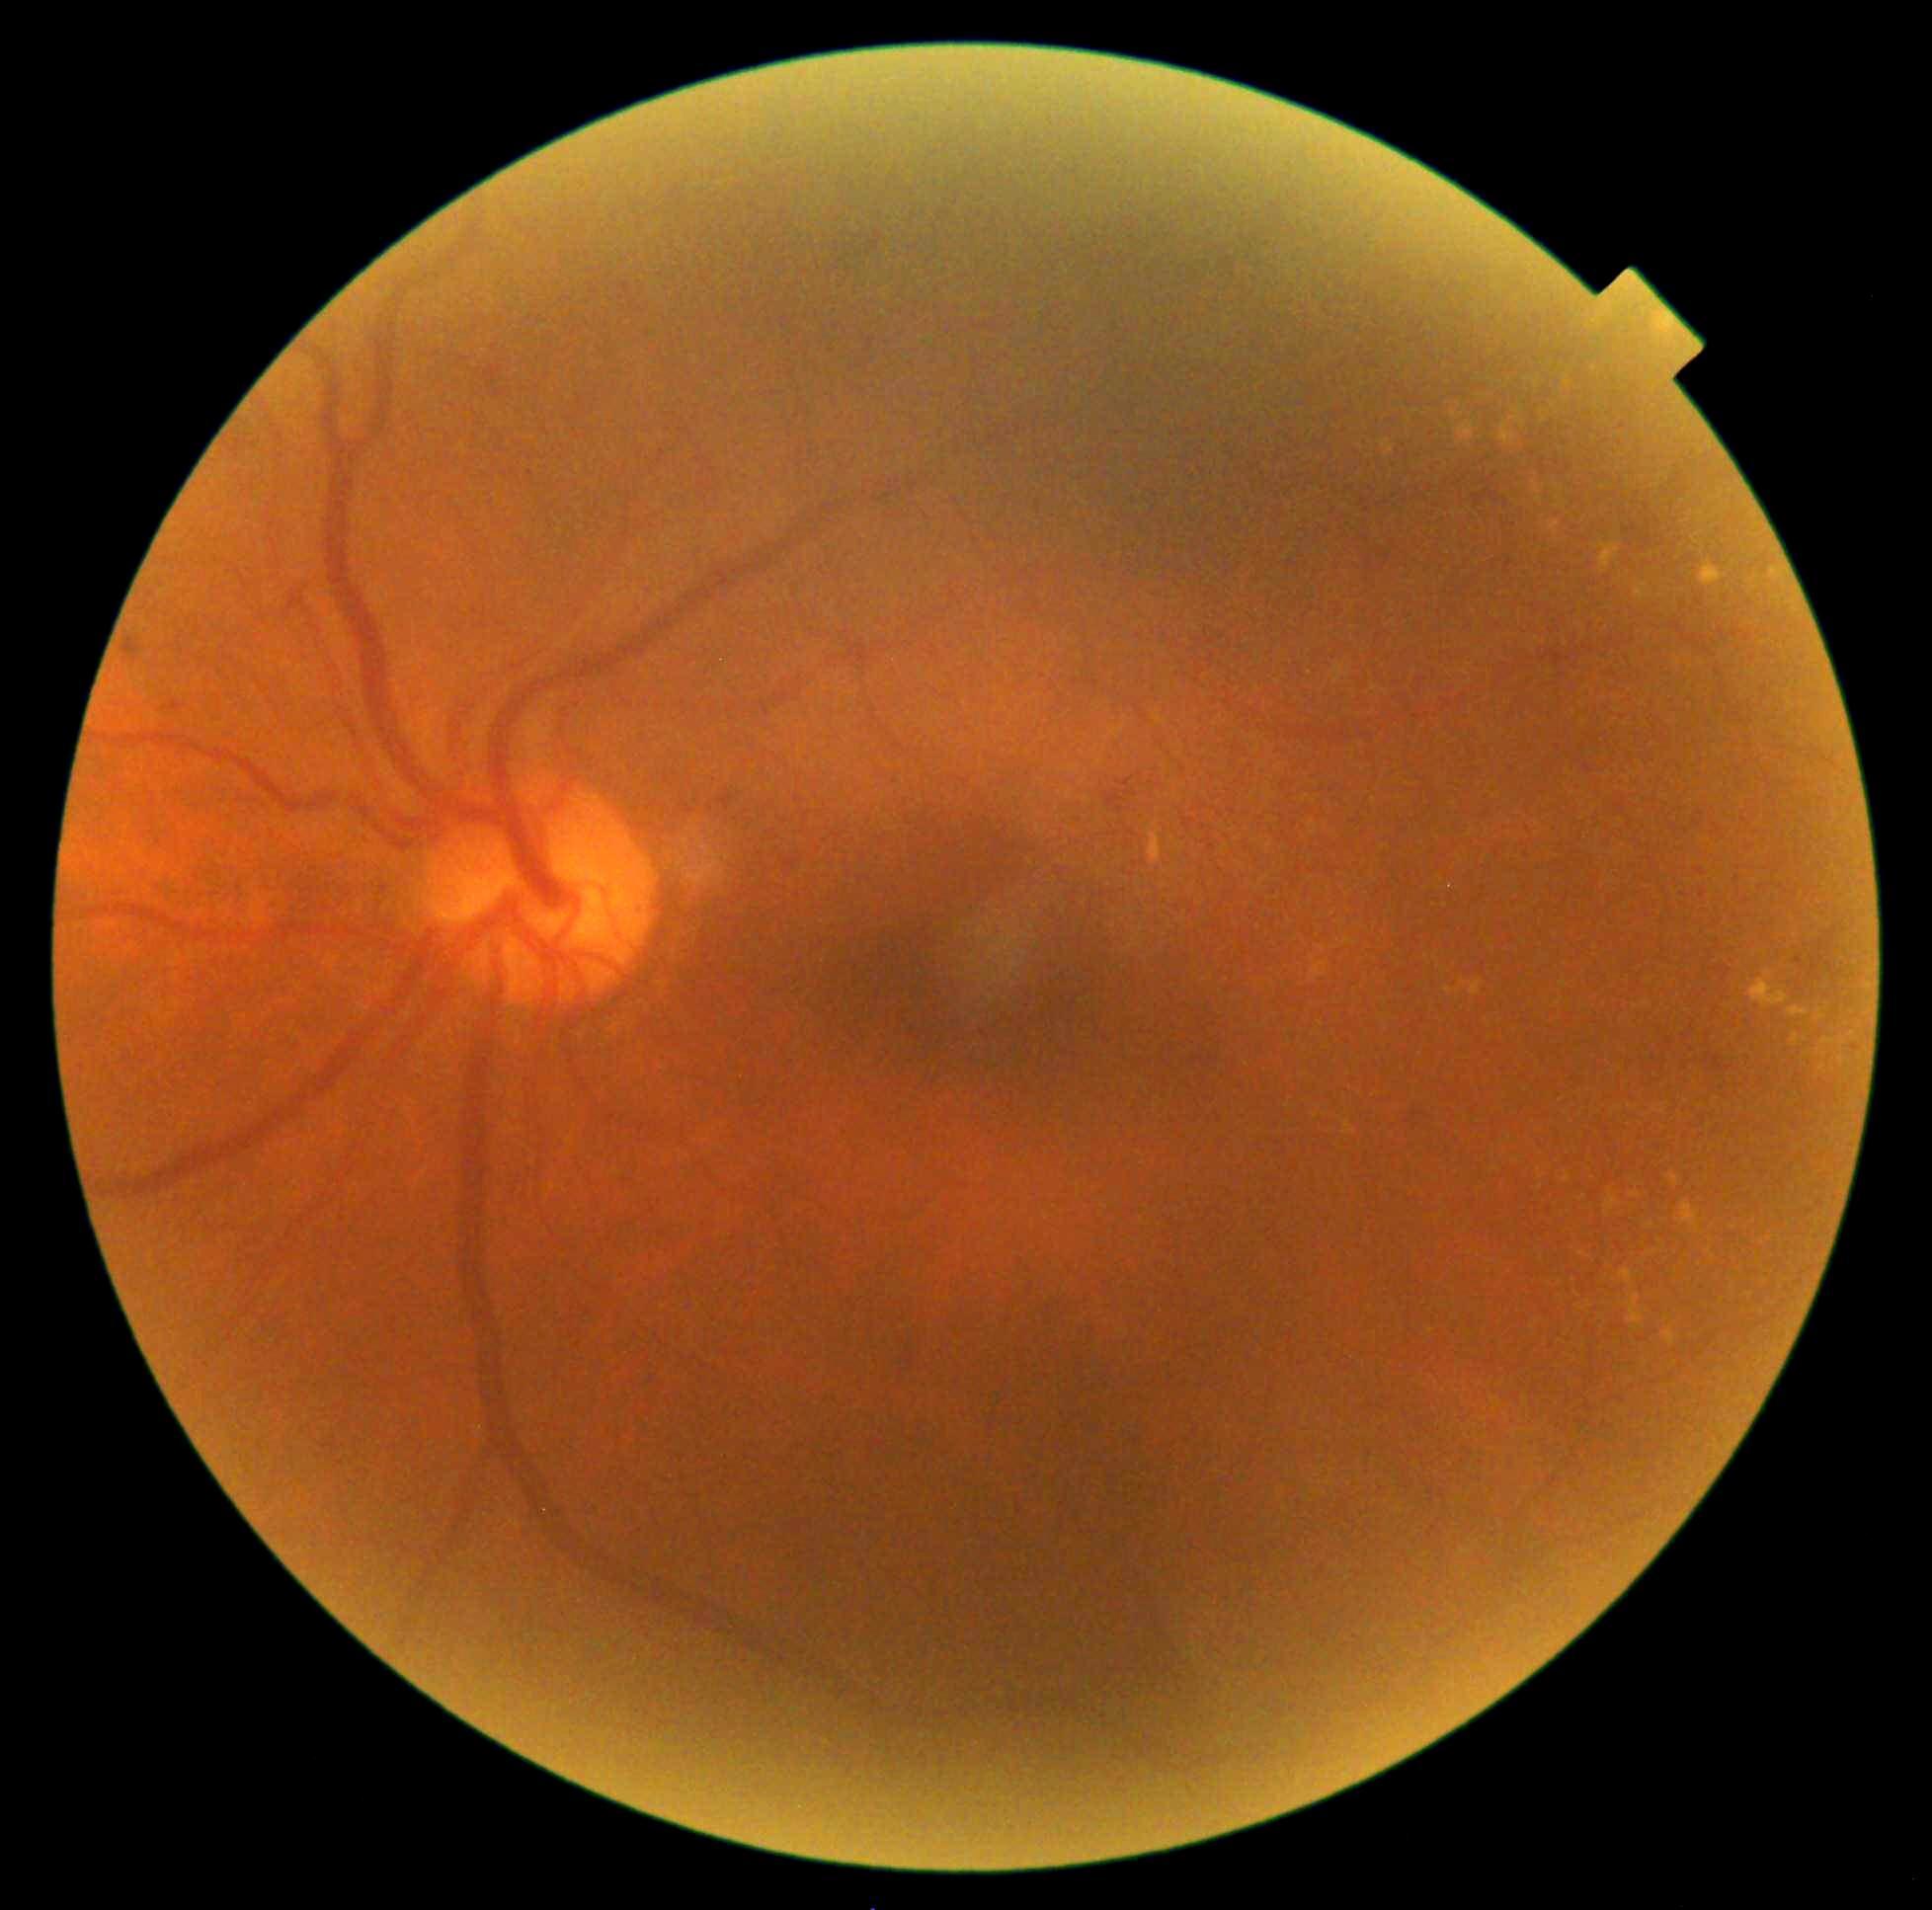

DR grade is 2
Representative lesions:
HEs: none
MAs (partial): x1=163, y1=701, x2=187, y2=712; x1=785, y1=860, x2=798, y2=869; x1=718, y1=790, x2=736, y2=812; x1=288, y1=592, x2=304, y2=611; x1=122, y1=638, x2=143, y2=664; x1=1473, y1=490, x2=1500, y2=508; x1=483, y1=366, x2=503, y2=390; x1=1705, y1=1053, x2=1735, y2=1073; x1=1104, y1=790, x2=1125, y2=814; x1=492, y1=390, x2=509, y2=399
Small MAs near 1407:1122; 1415:1115; 480:371
SEs: none
EXs (partial): x1=1626, y1=1295, x2=1644, y2=1330; x1=1501, y1=422, x2=1517, y2=443; x1=1787, y1=1006, x2=1811, y2=1017; x1=1749, y1=980, x2=1789, y2=1008; x1=1771, y1=569, x2=1786, y2=580; x1=1471, y1=980, x2=1483, y2=996; x1=1564, y1=1173, x2=1570, y2=1184; x1=1445, y1=987, x2=1453, y2=995
Small EXs near 1322:949; 1853:1034; 1710:1251; 1416:412; 1823:1069; 1841:1060; 1516:1161; 1583:1199